848x848px, 45° FOV, graded on the modified Davis scale
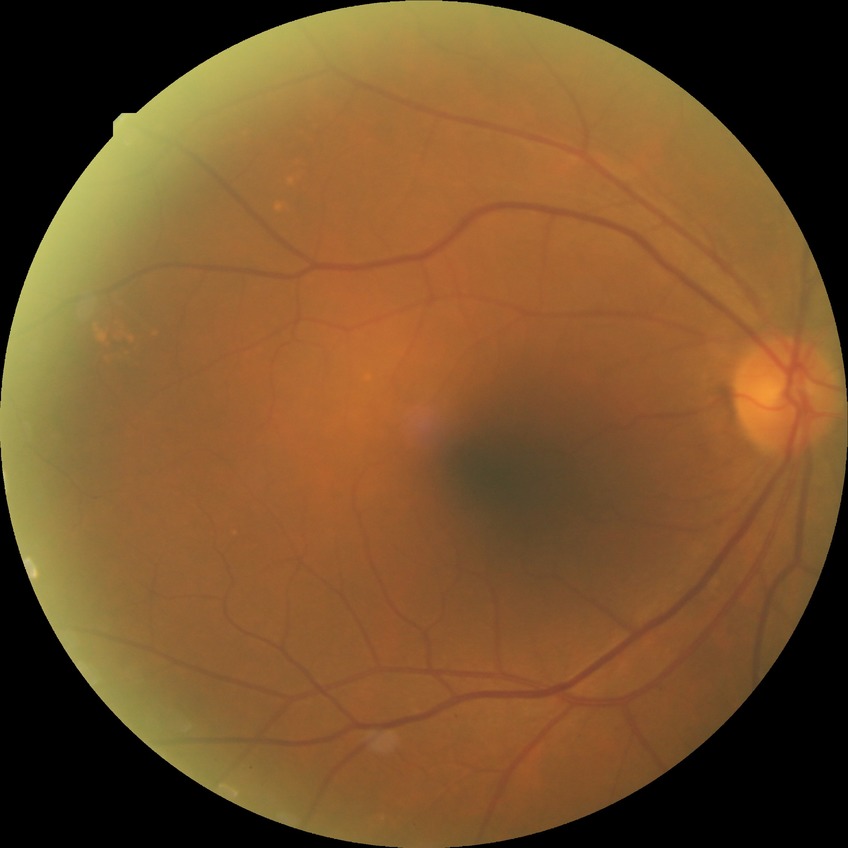

Diabetic retinopathy (DR) is NDR (no diabetic retinopathy).